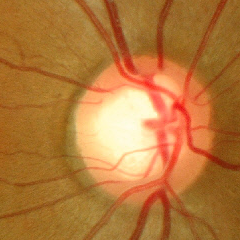

Glaucoma assessment = early-stage glaucoma. (Criteria: glaucomatous retinal nerve fiber layer defects on red-free fundus photography without visual field defects.)